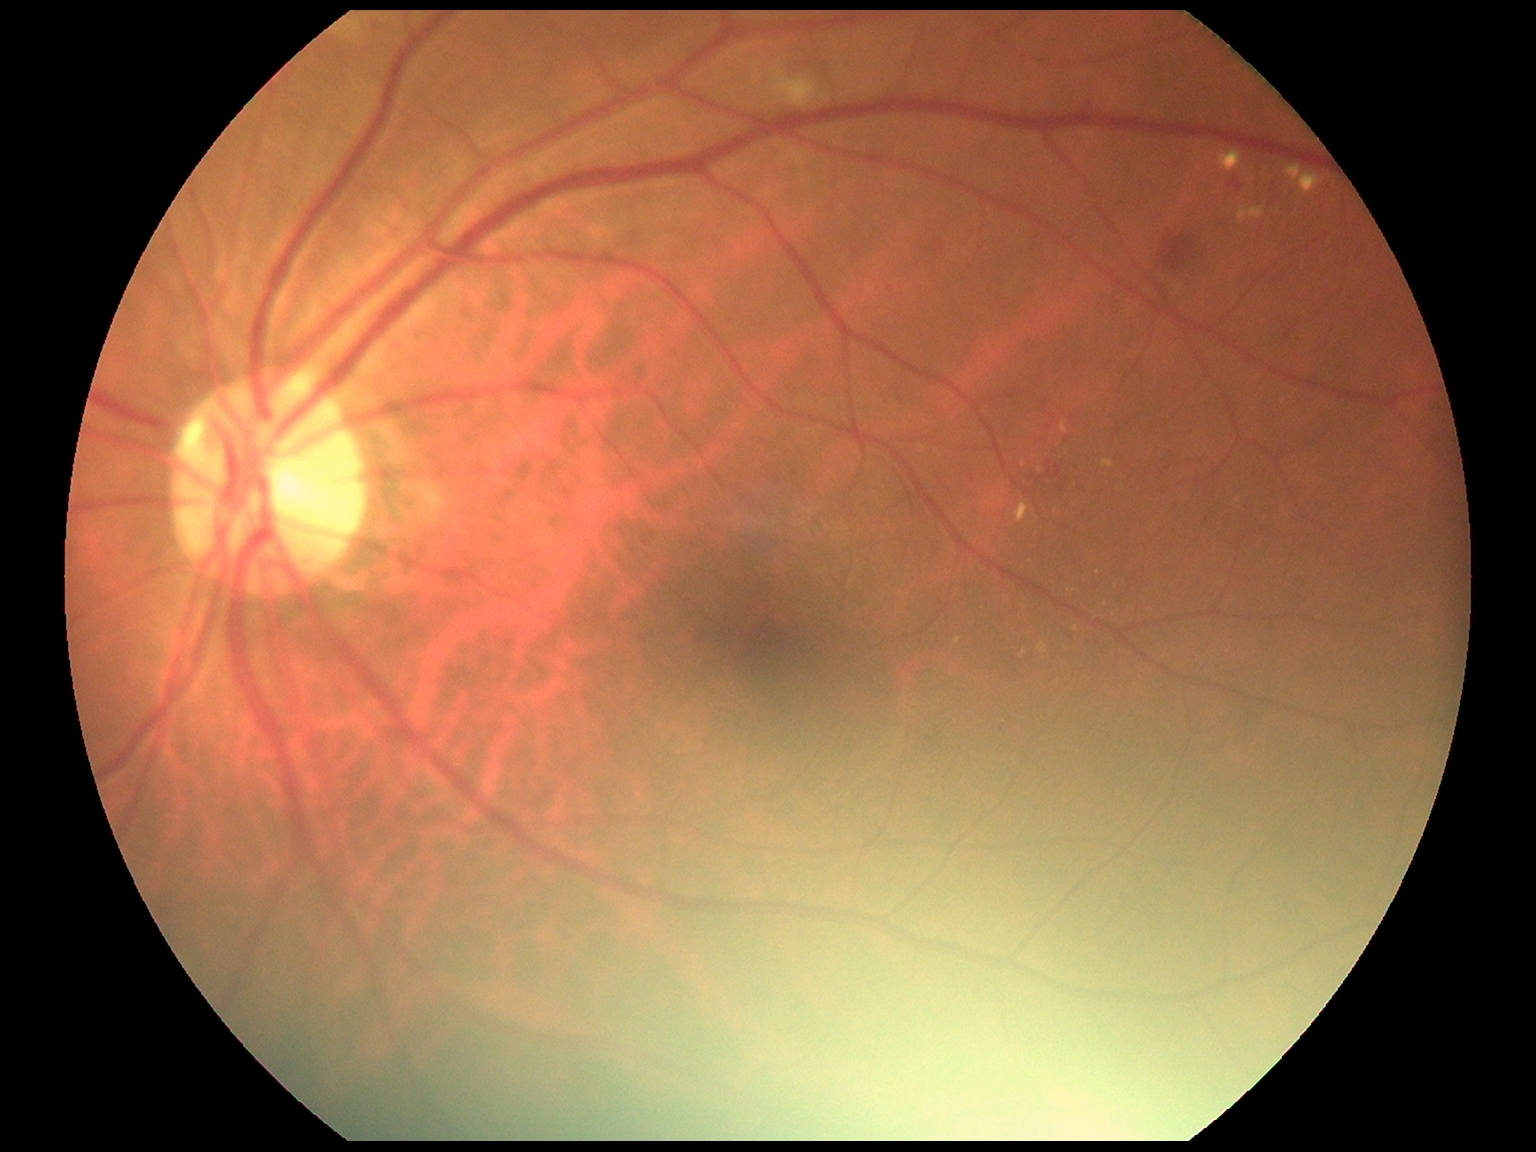 DR severity: grade 2 (moderate NPDR).